RetCam wide-field infant fundus image; 1440x1080px: 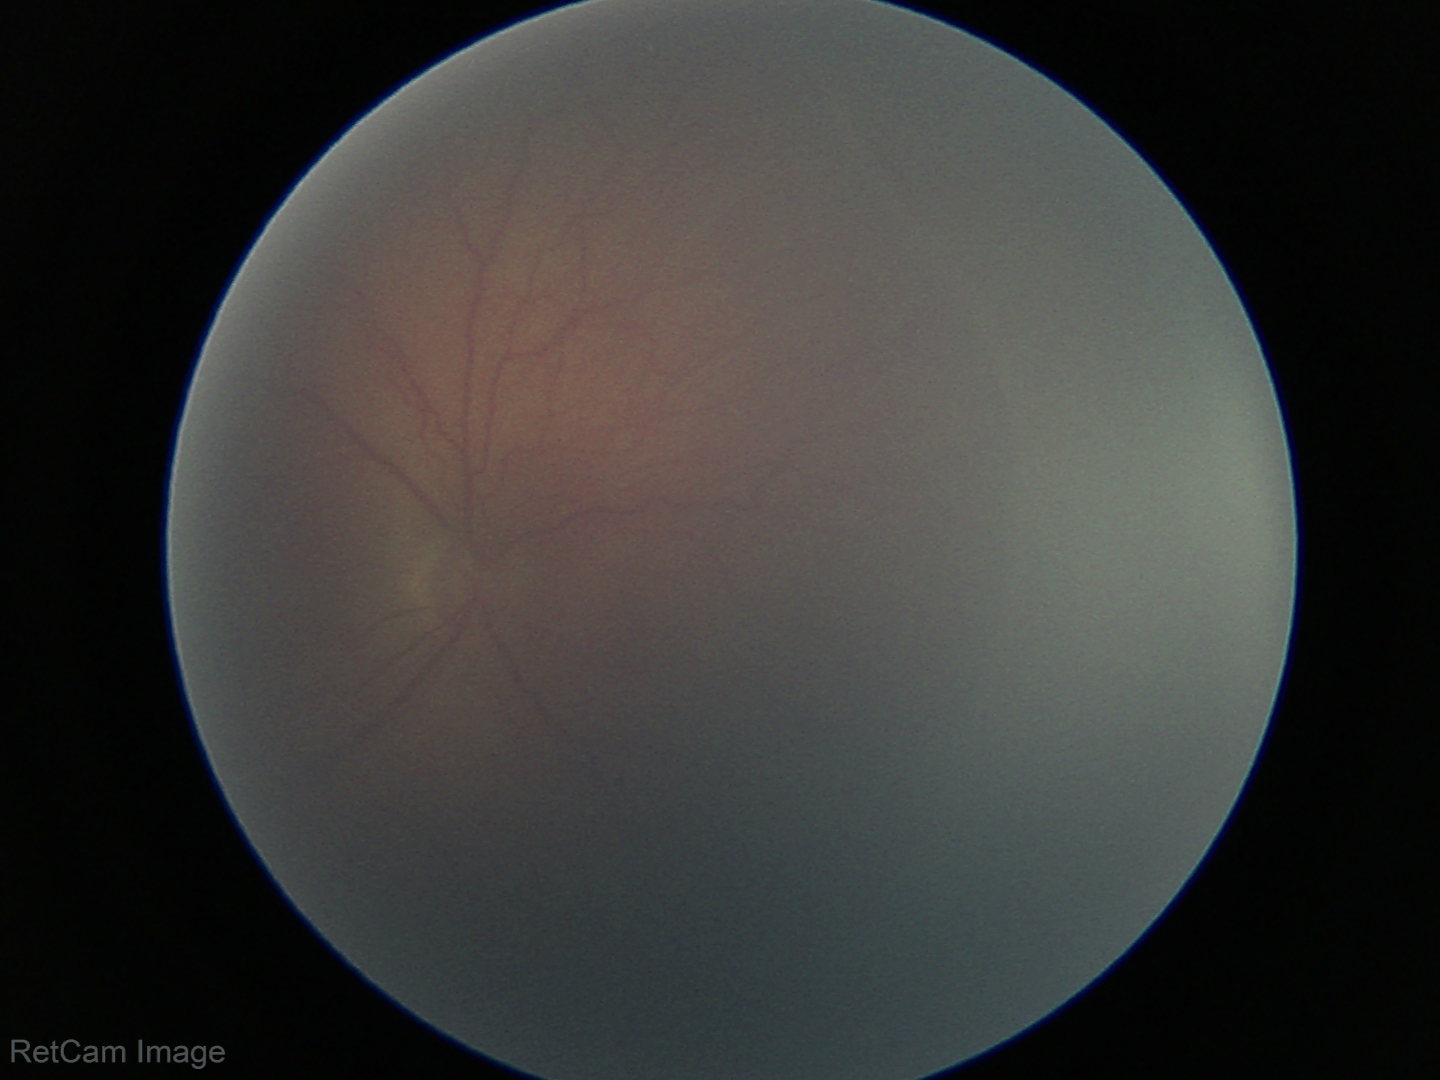 Diagnosis from this screening exam: retinopathy of prematurity stage 2.
No plus disease.